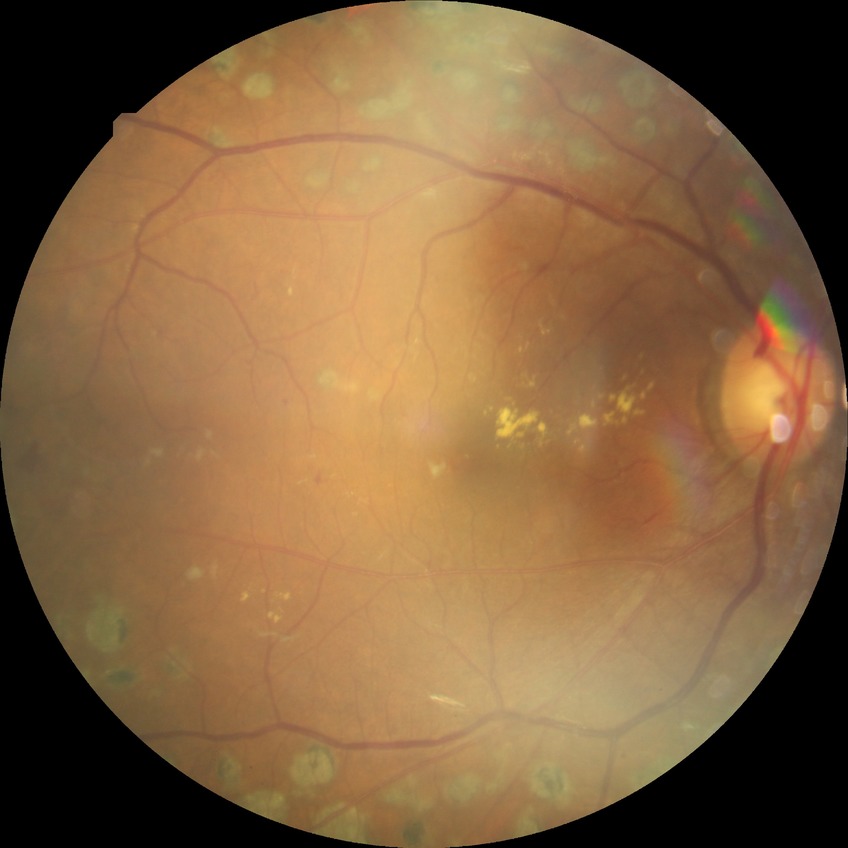 Diabetic retinopathy (DR) is proliferative diabetic retinopathy (PDR).